2102x1736px — 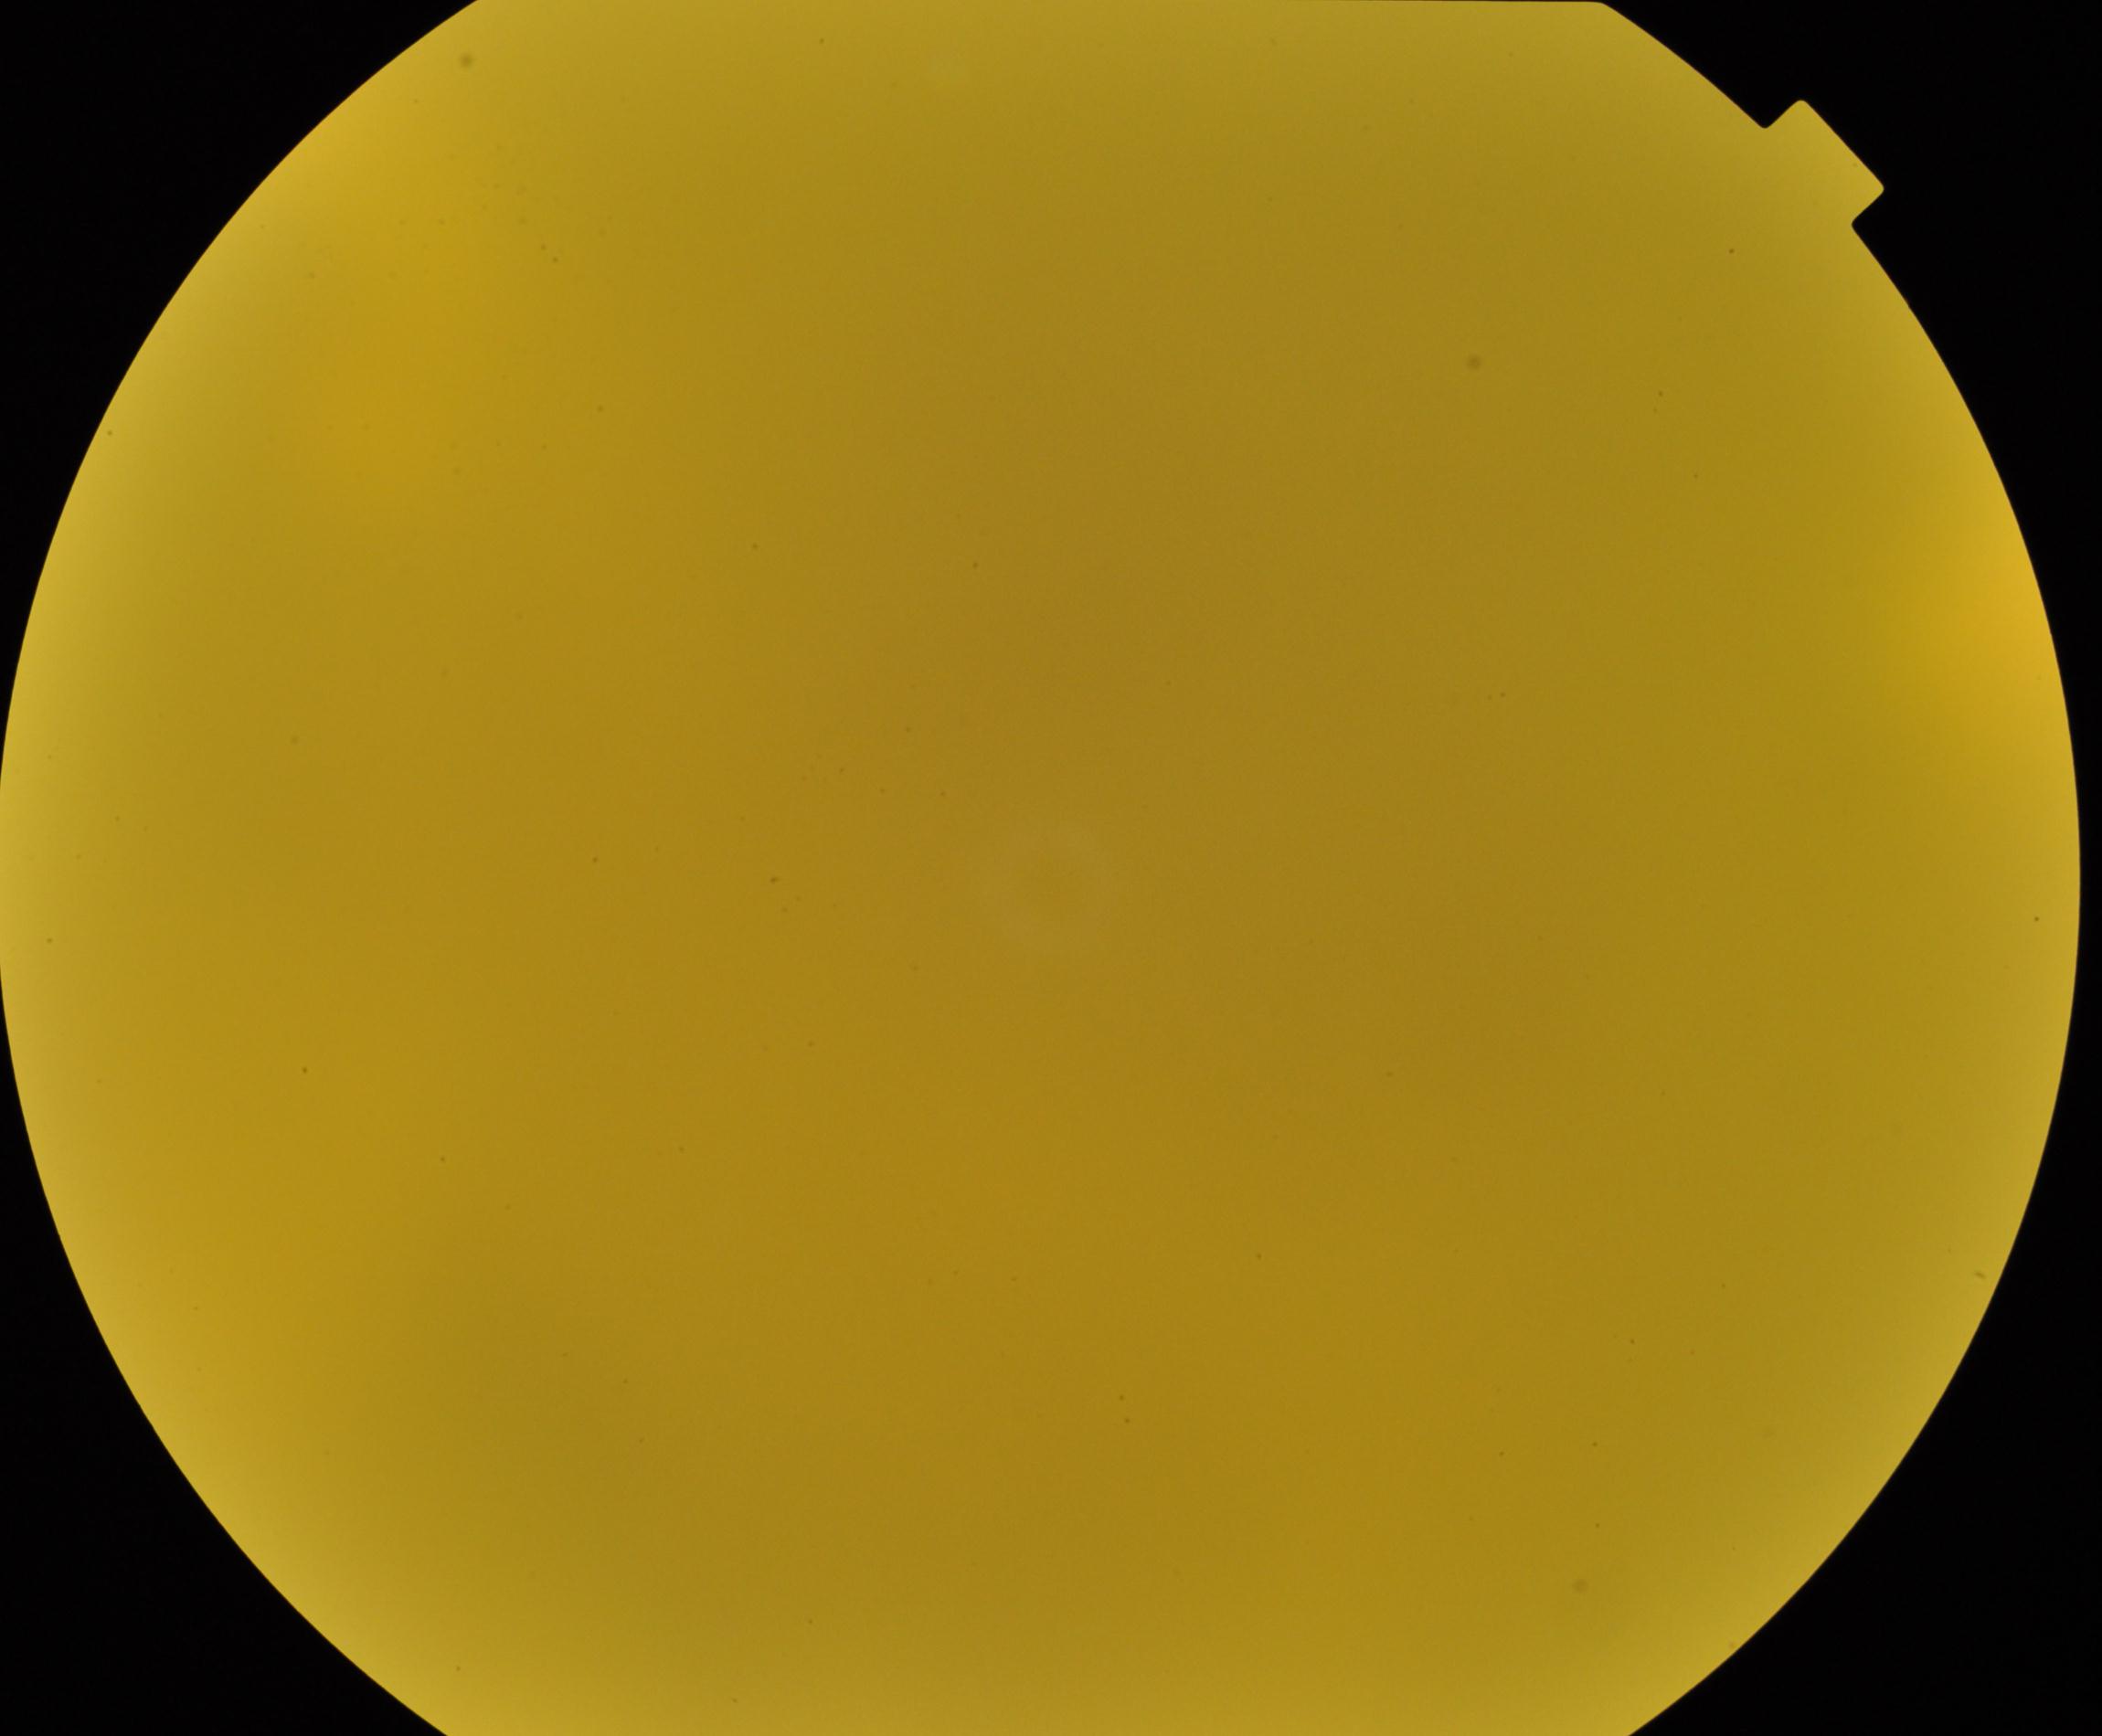
Quality: significantly degraded.
Proliferative retinopathy: no evidence.